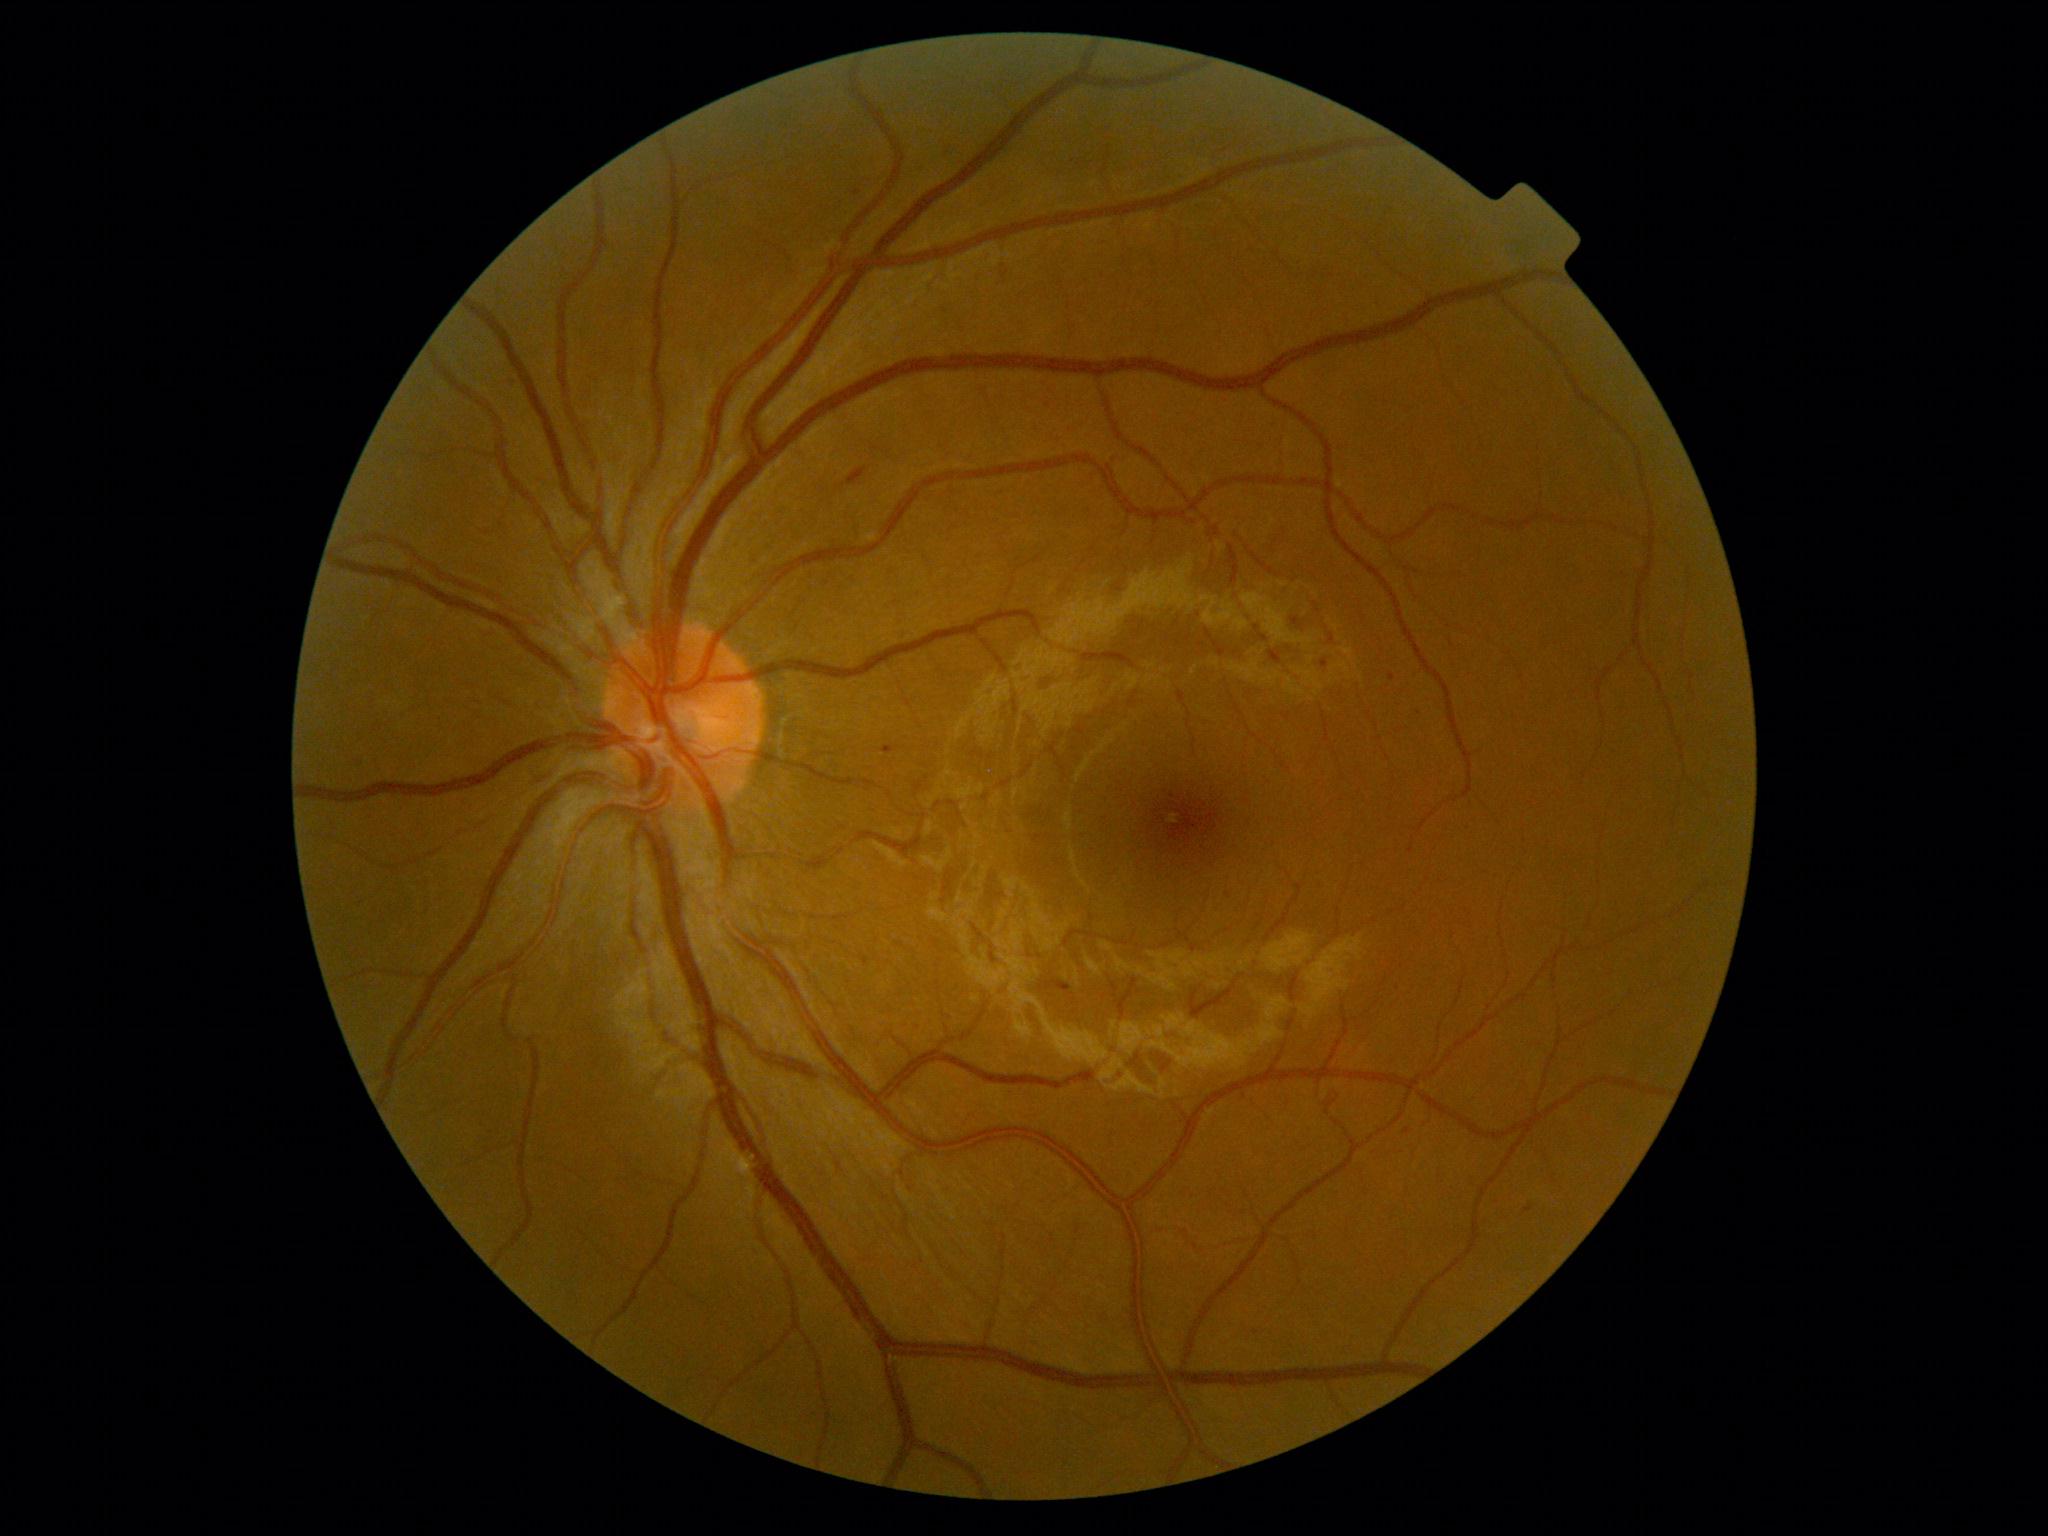
dr_grade: moderate non-proliferative diabetic retinopathy (grade 2)